FOV: 45 degrees
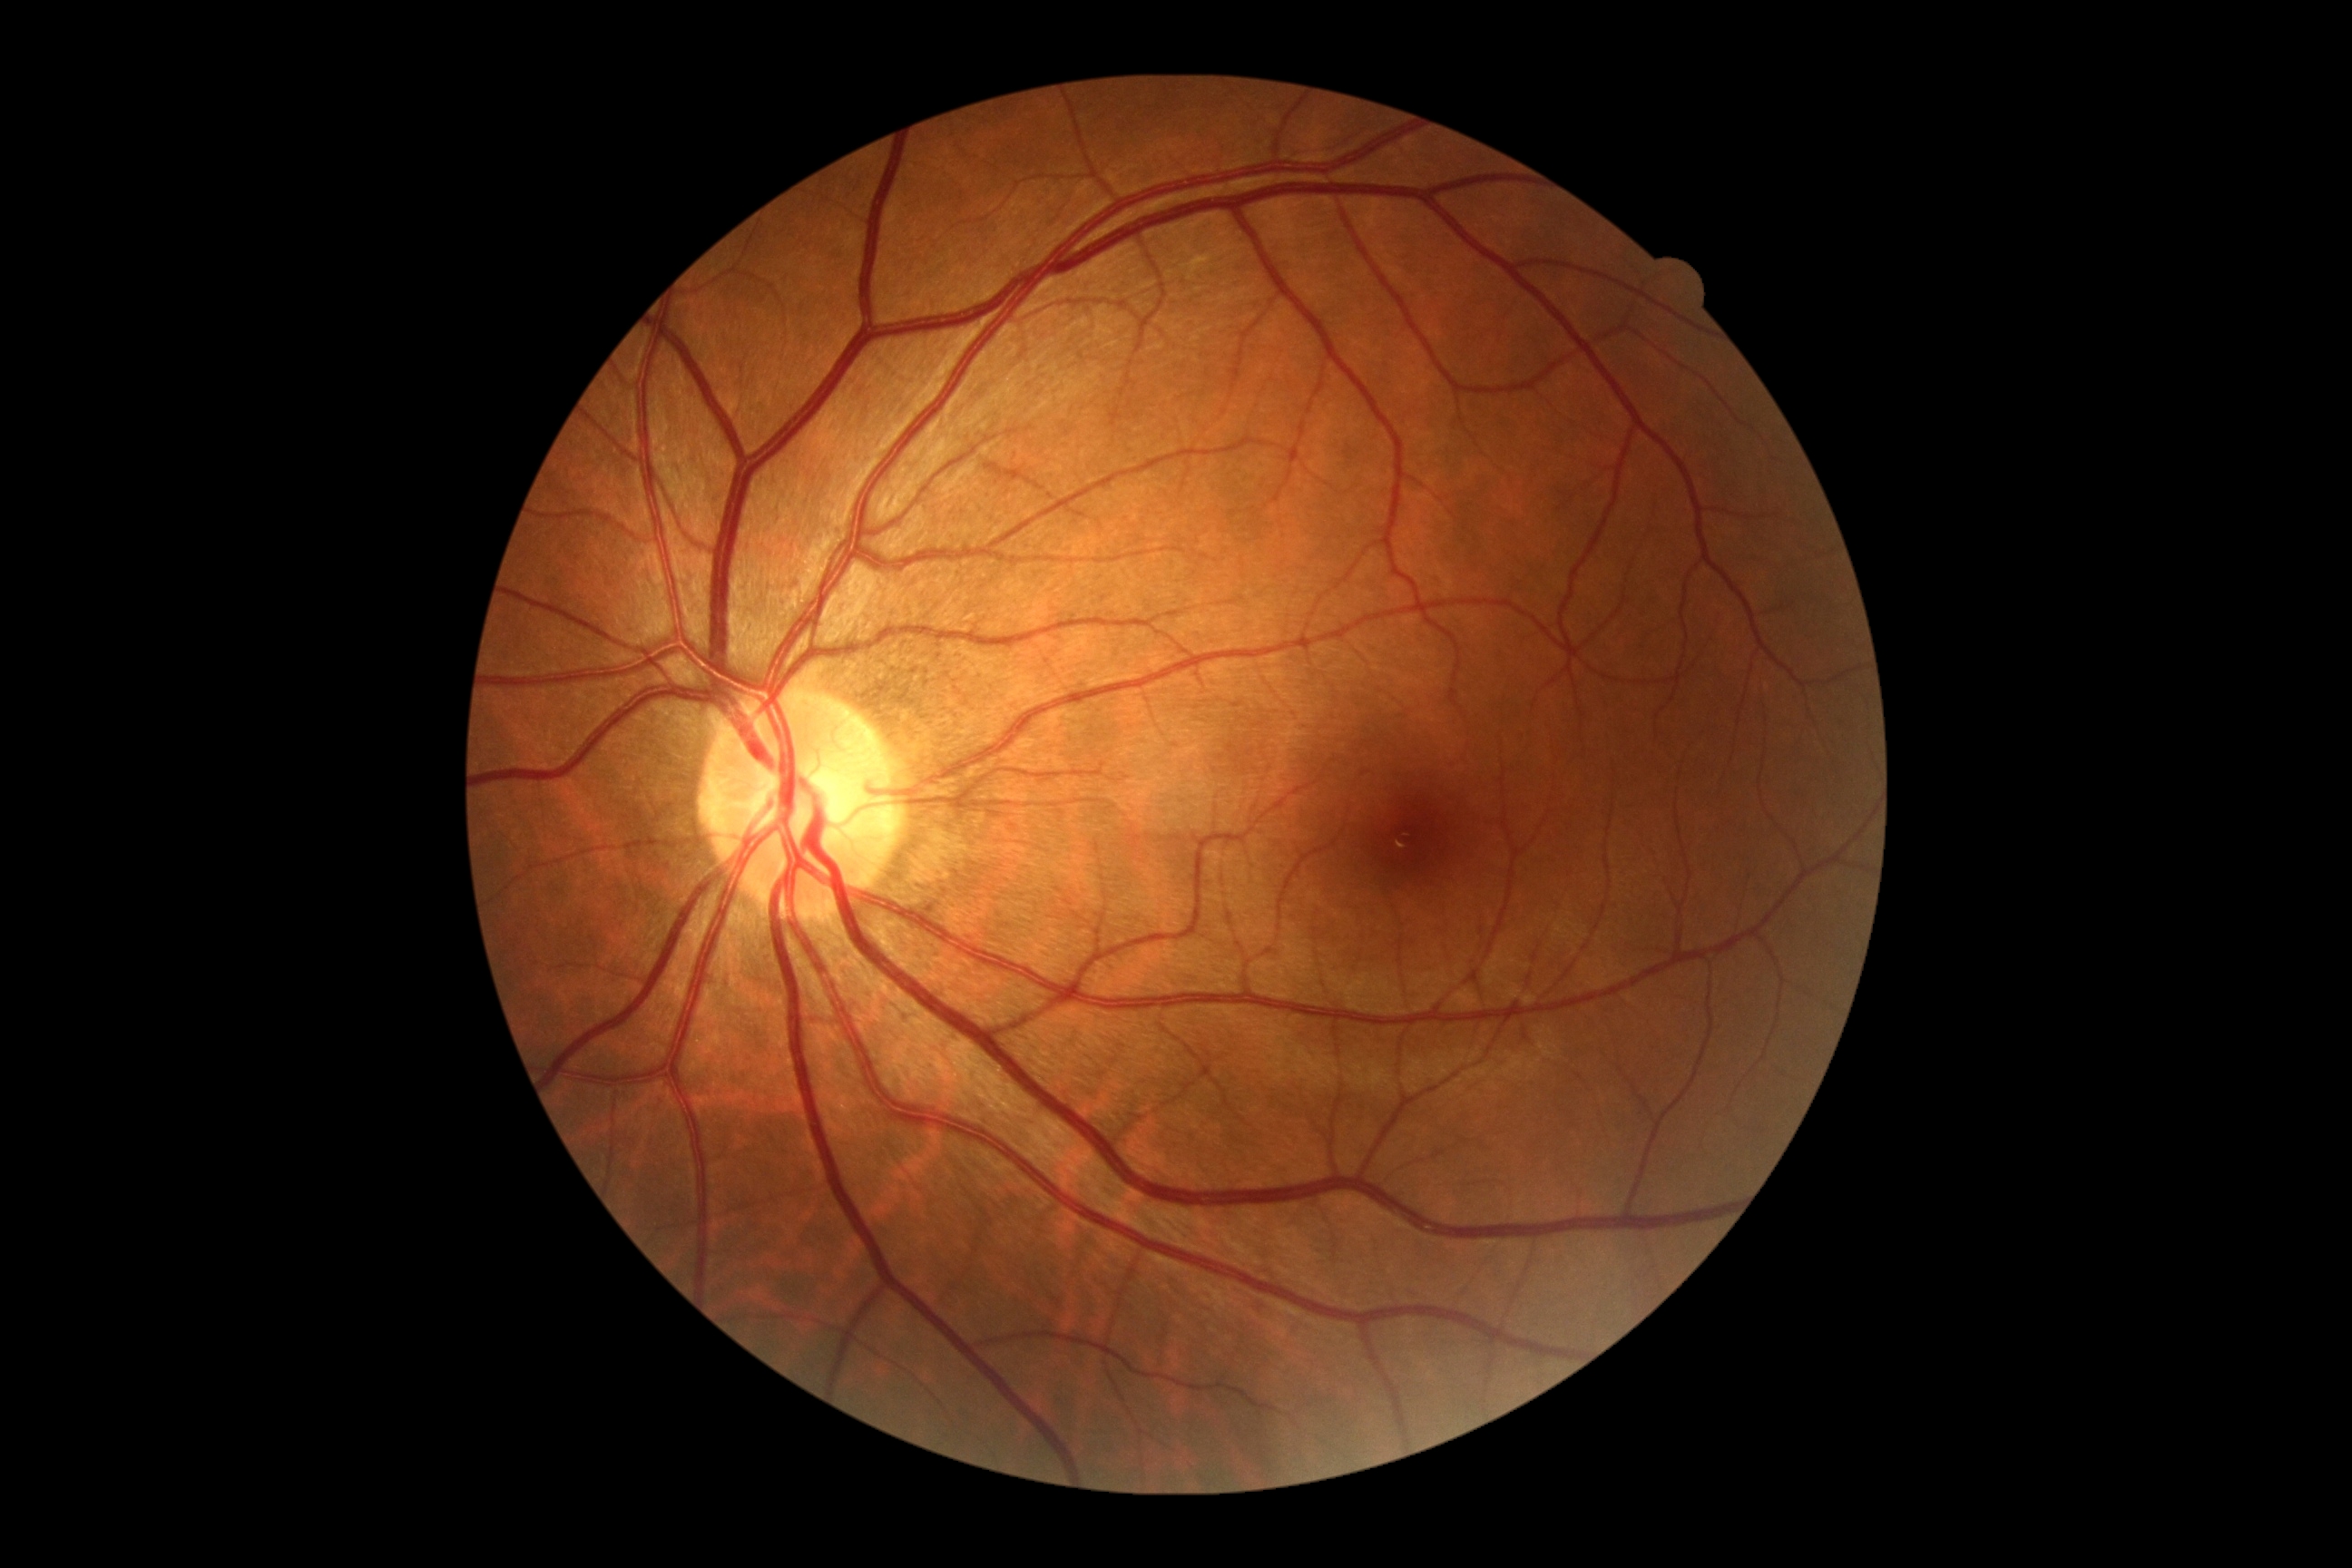 Annotations:
– DR severity: grade 0
– DR impression: no apparent DR